Wide-field fundus photograph from neonatal ROP screening — 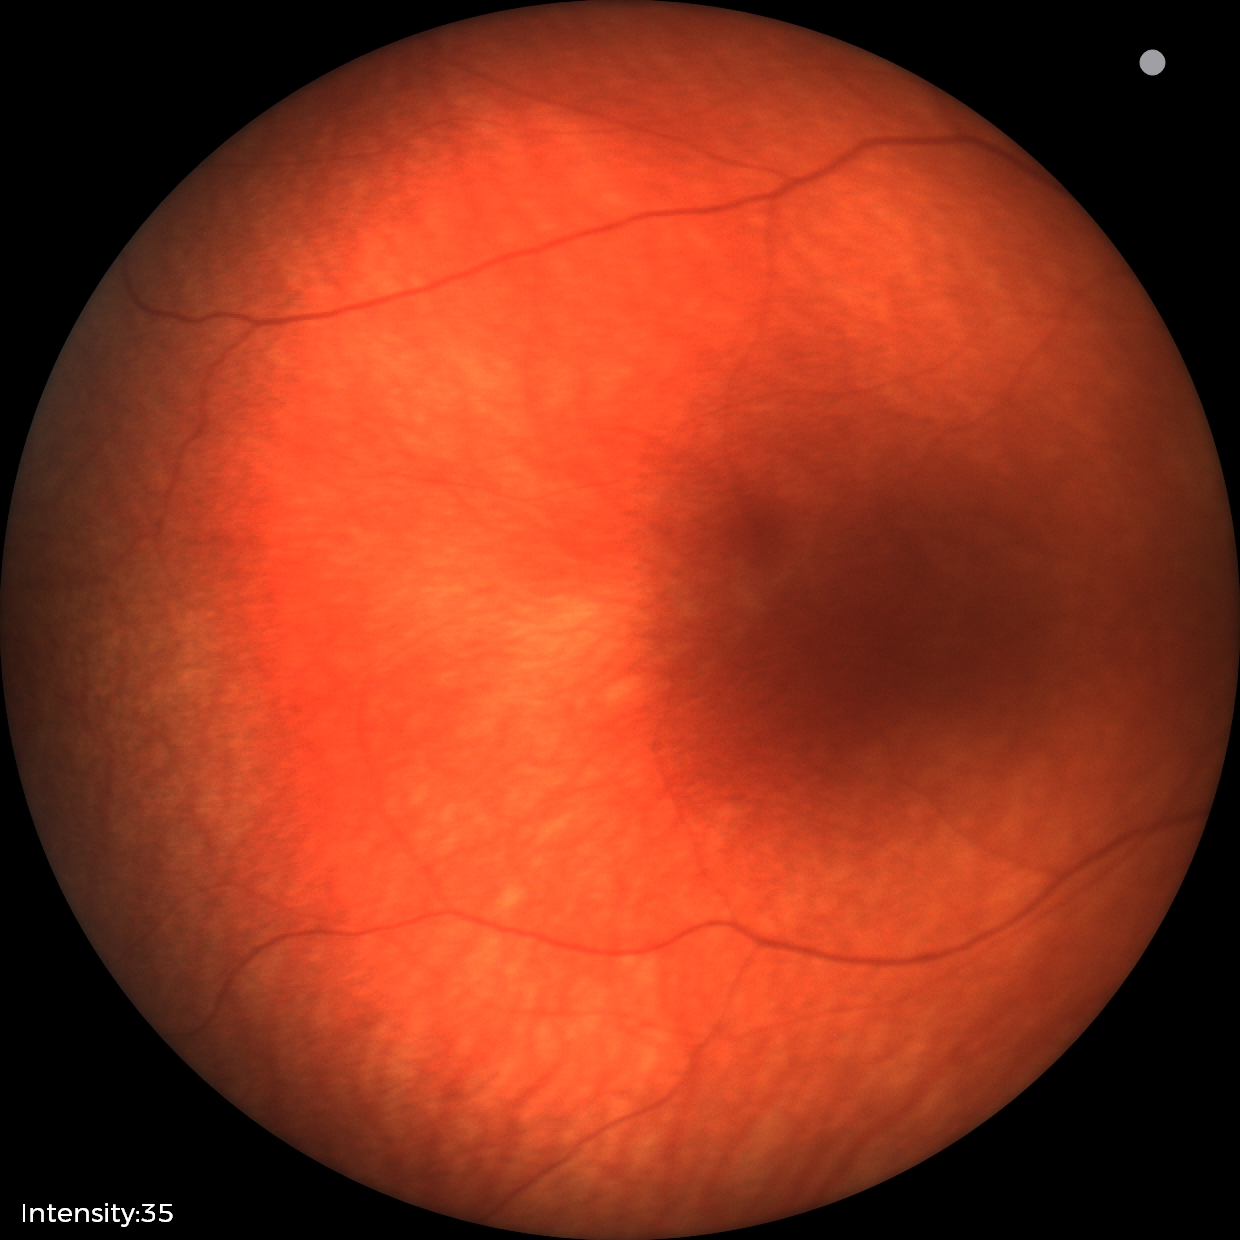 Q: What is the screening diagnosis?
A: physiological appearance with no retinal pathology